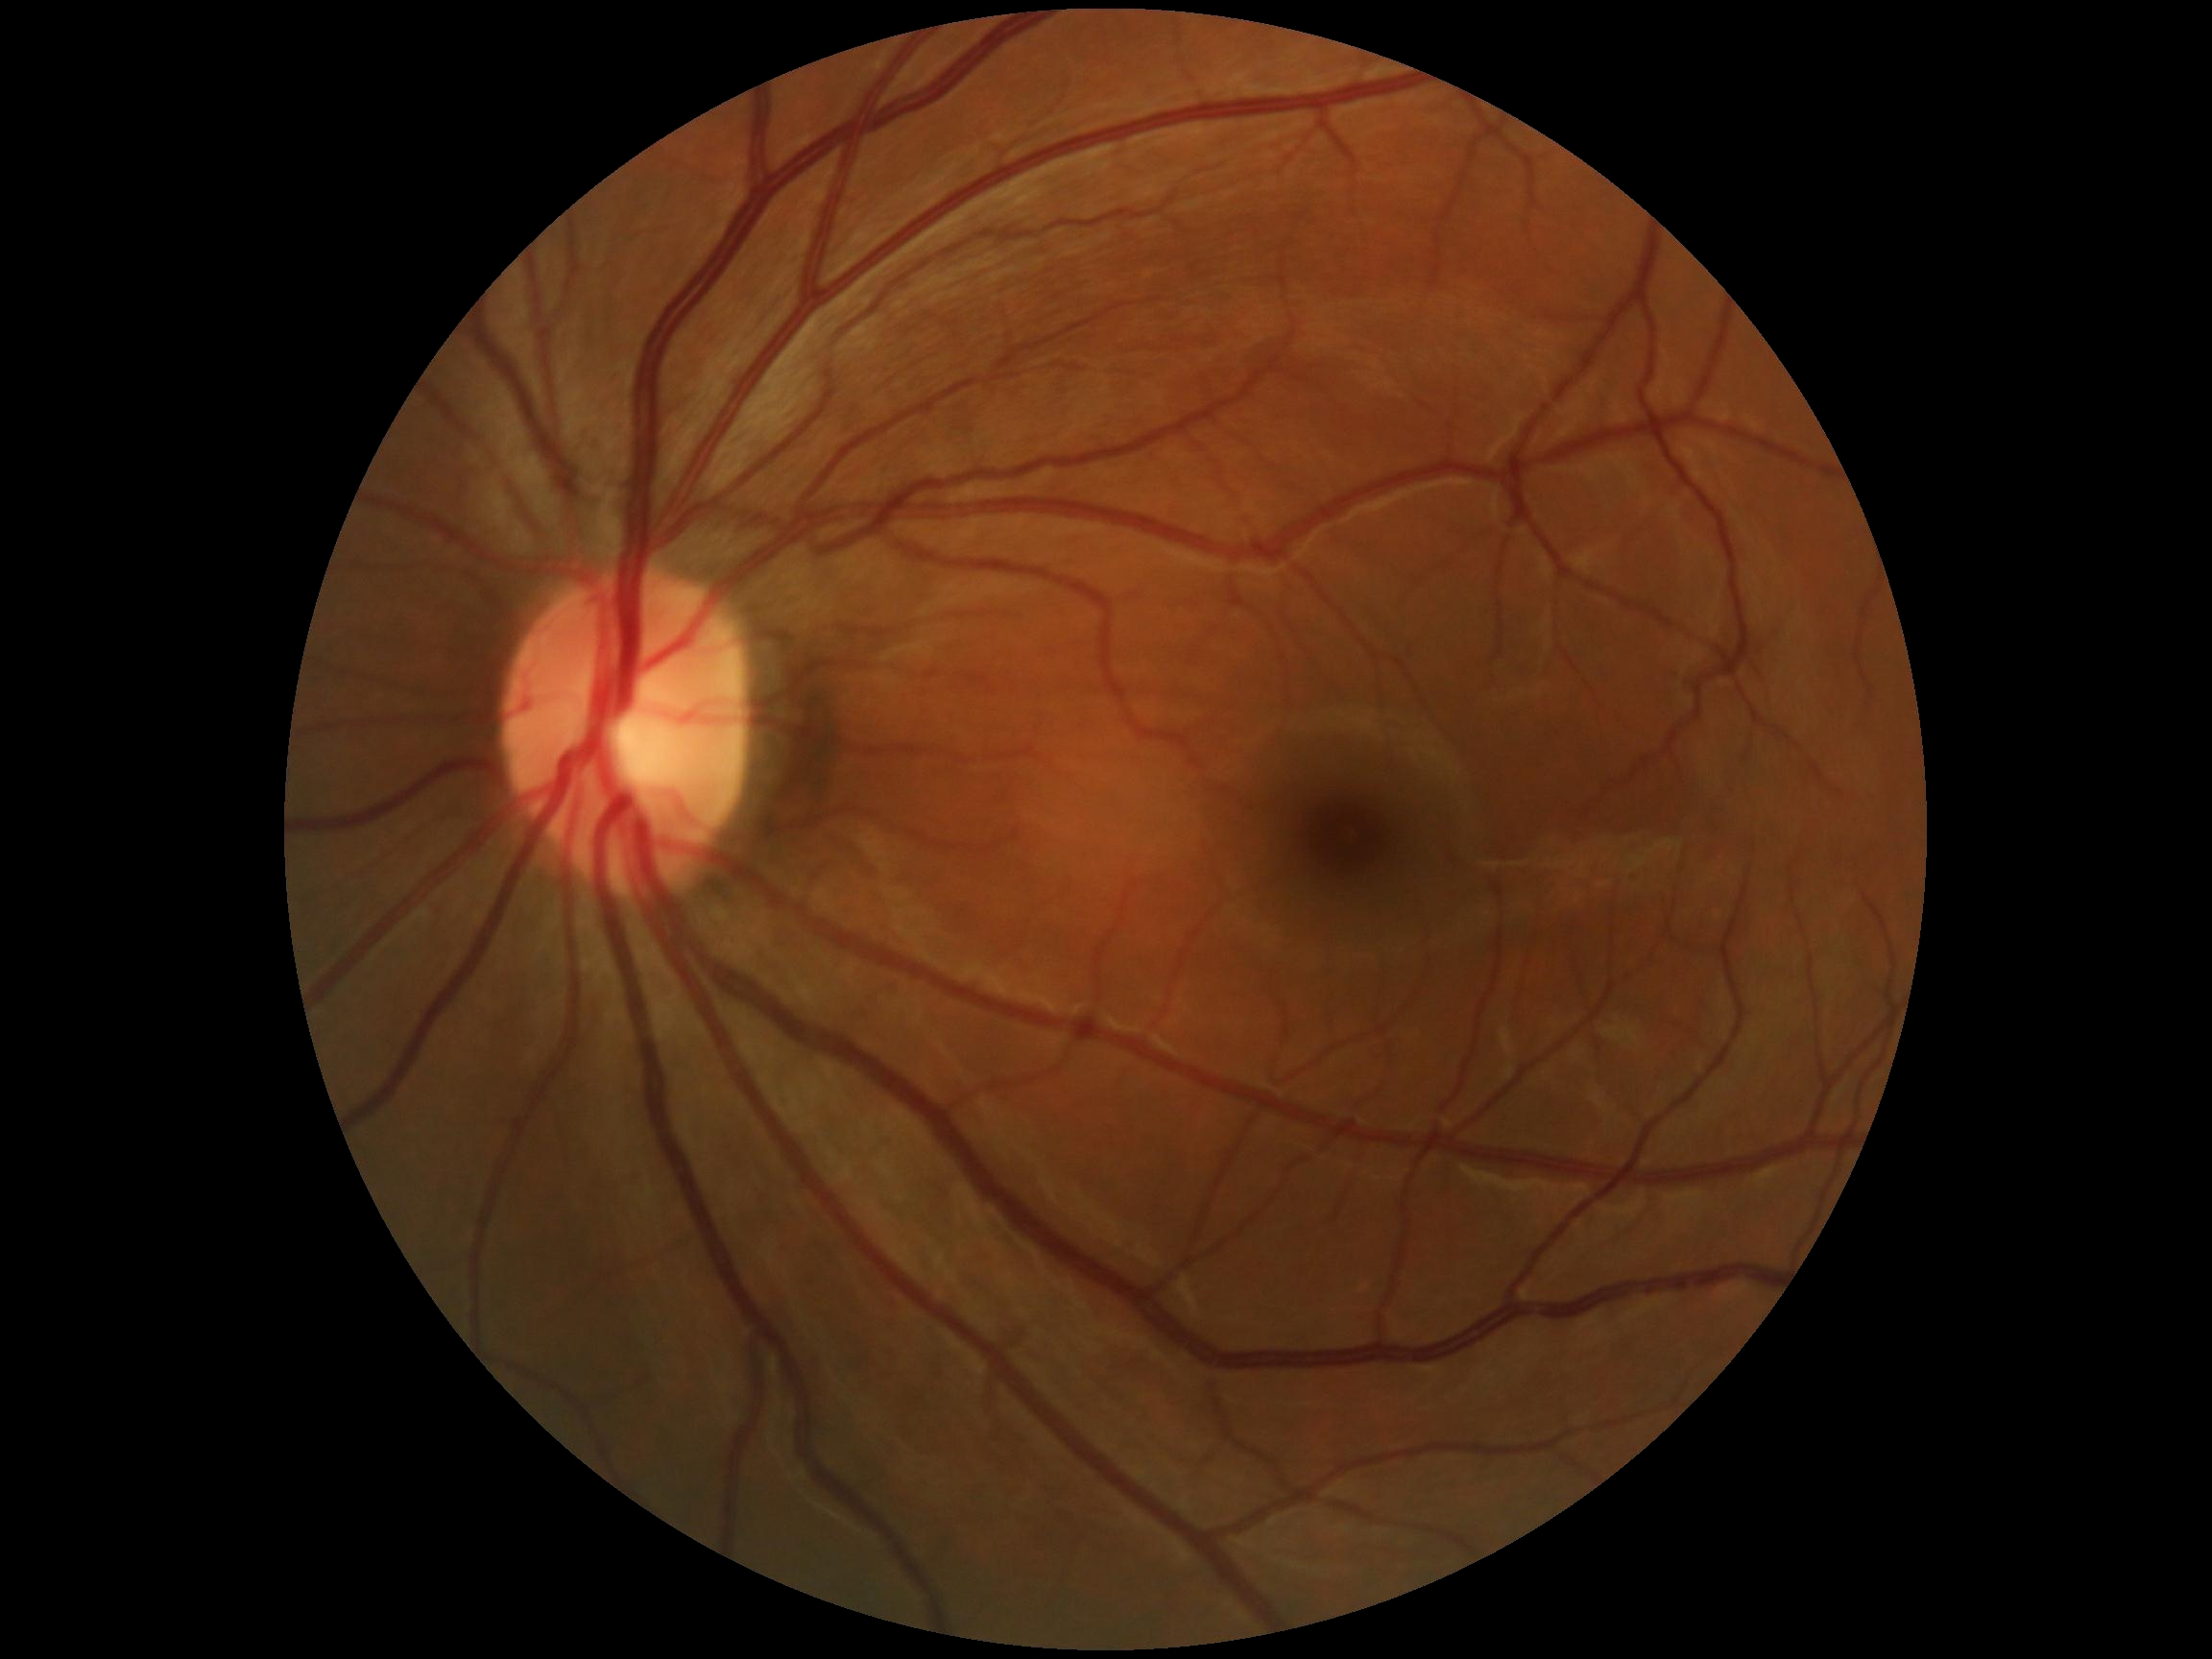 DR impression=no DR findings; diabetic retinopathy severity=0/4.